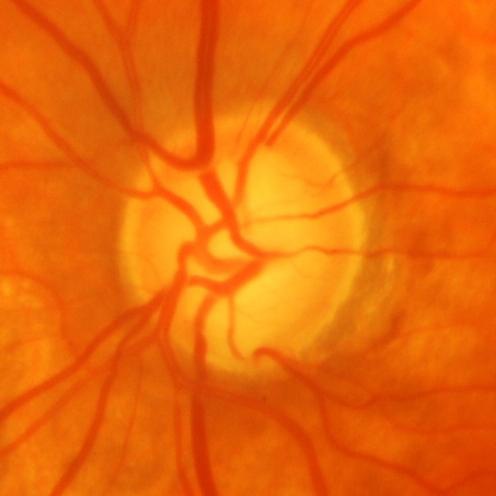
Q: Is glaucoma present?
A: Yes — glaucomatous damage to the optic nerve.